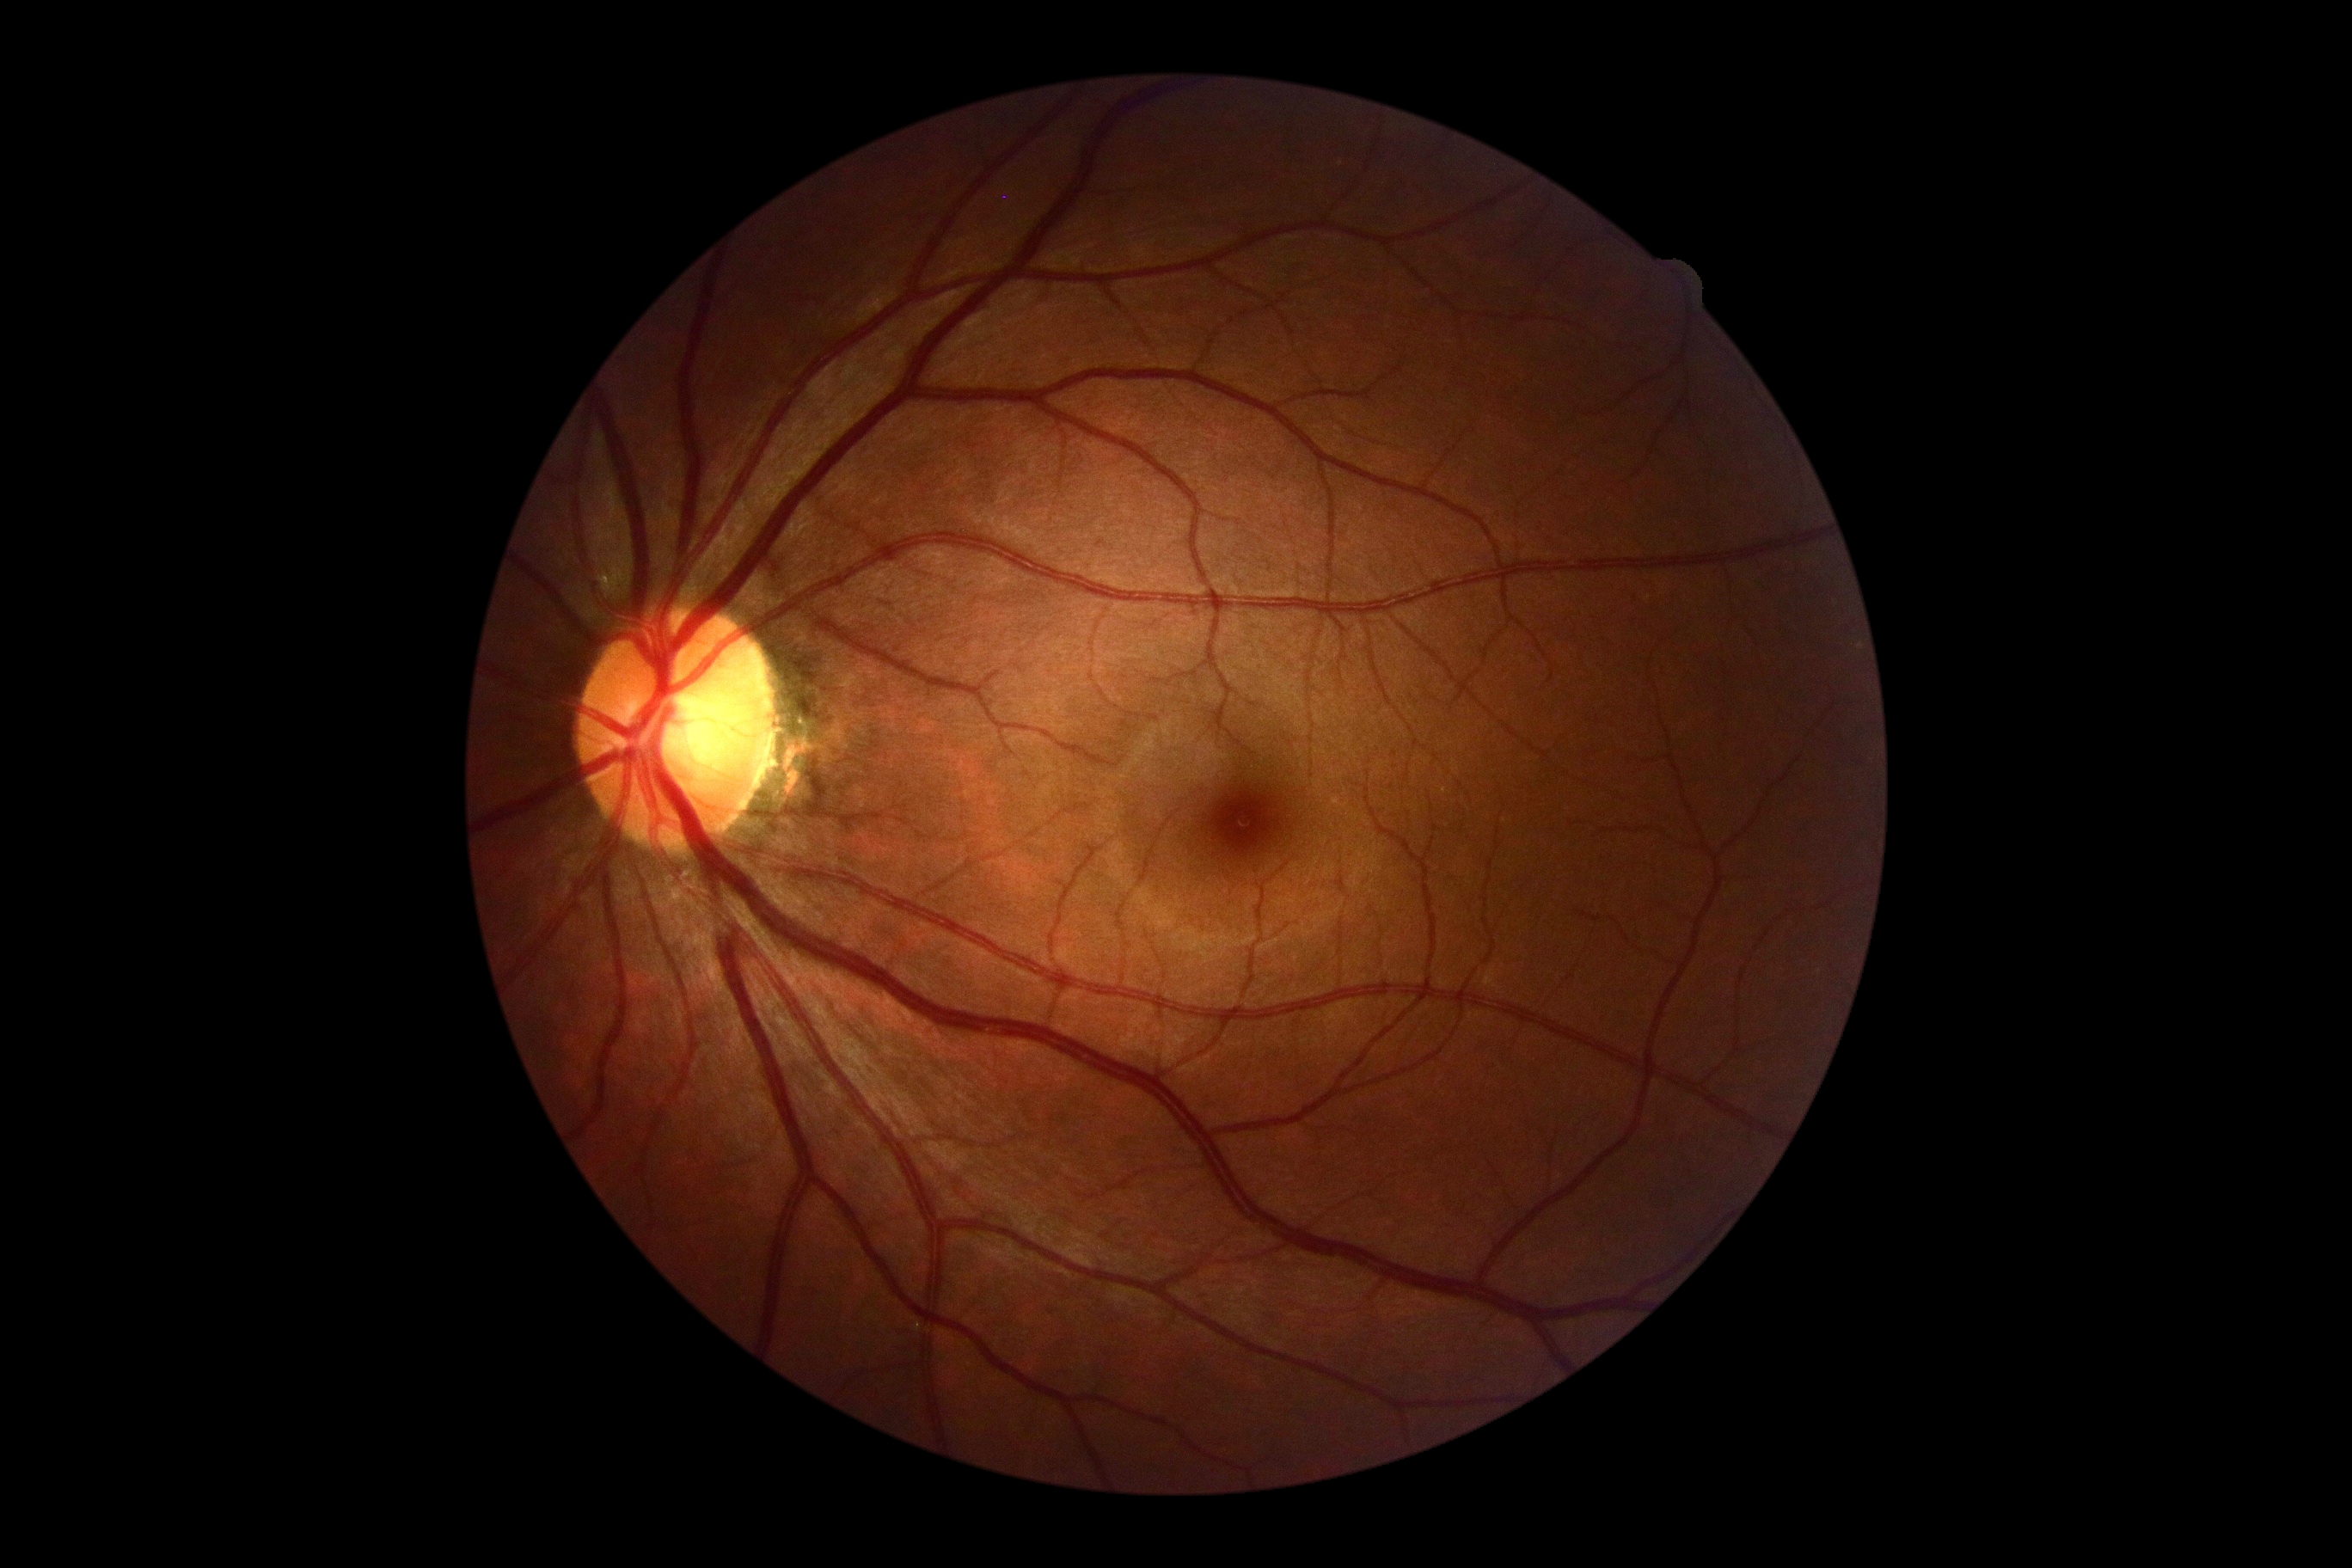
* diabetic retinopathy severity — no apparent diabetic retinopathy (grade 0) — no visible signs of diabetic retinopathy